Diabetic retinopathy graded by the modified Davis classification:
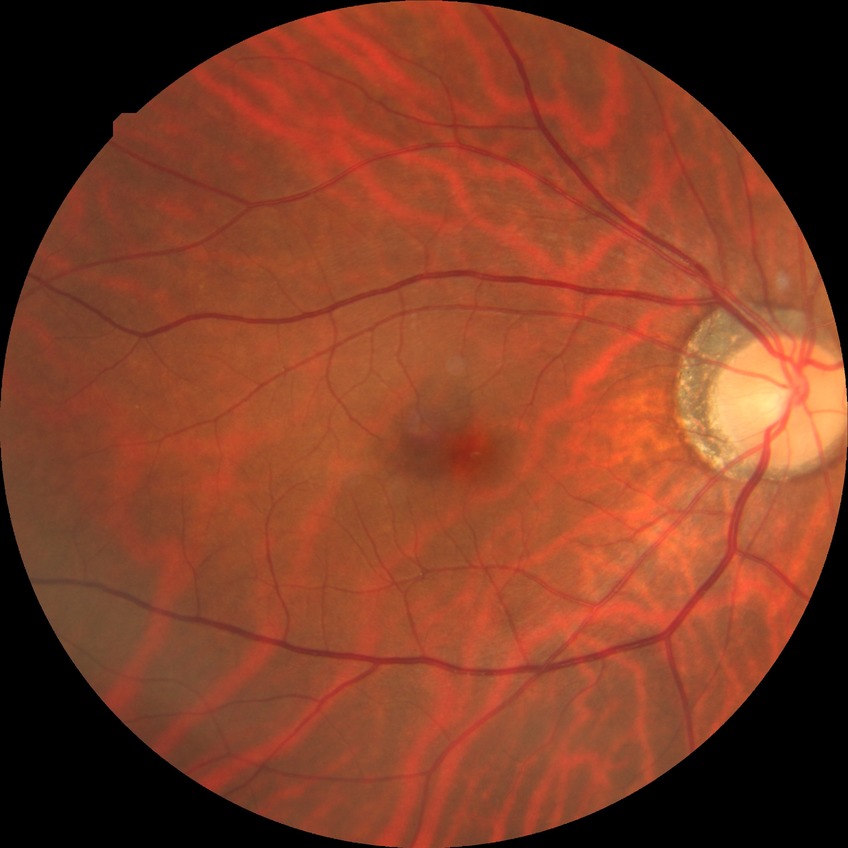 Davis grade = NDR.